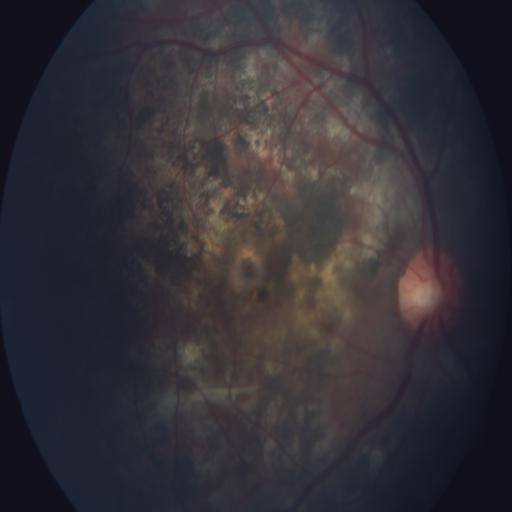
Color fundus photograph showing CRS (chorioretinitis).